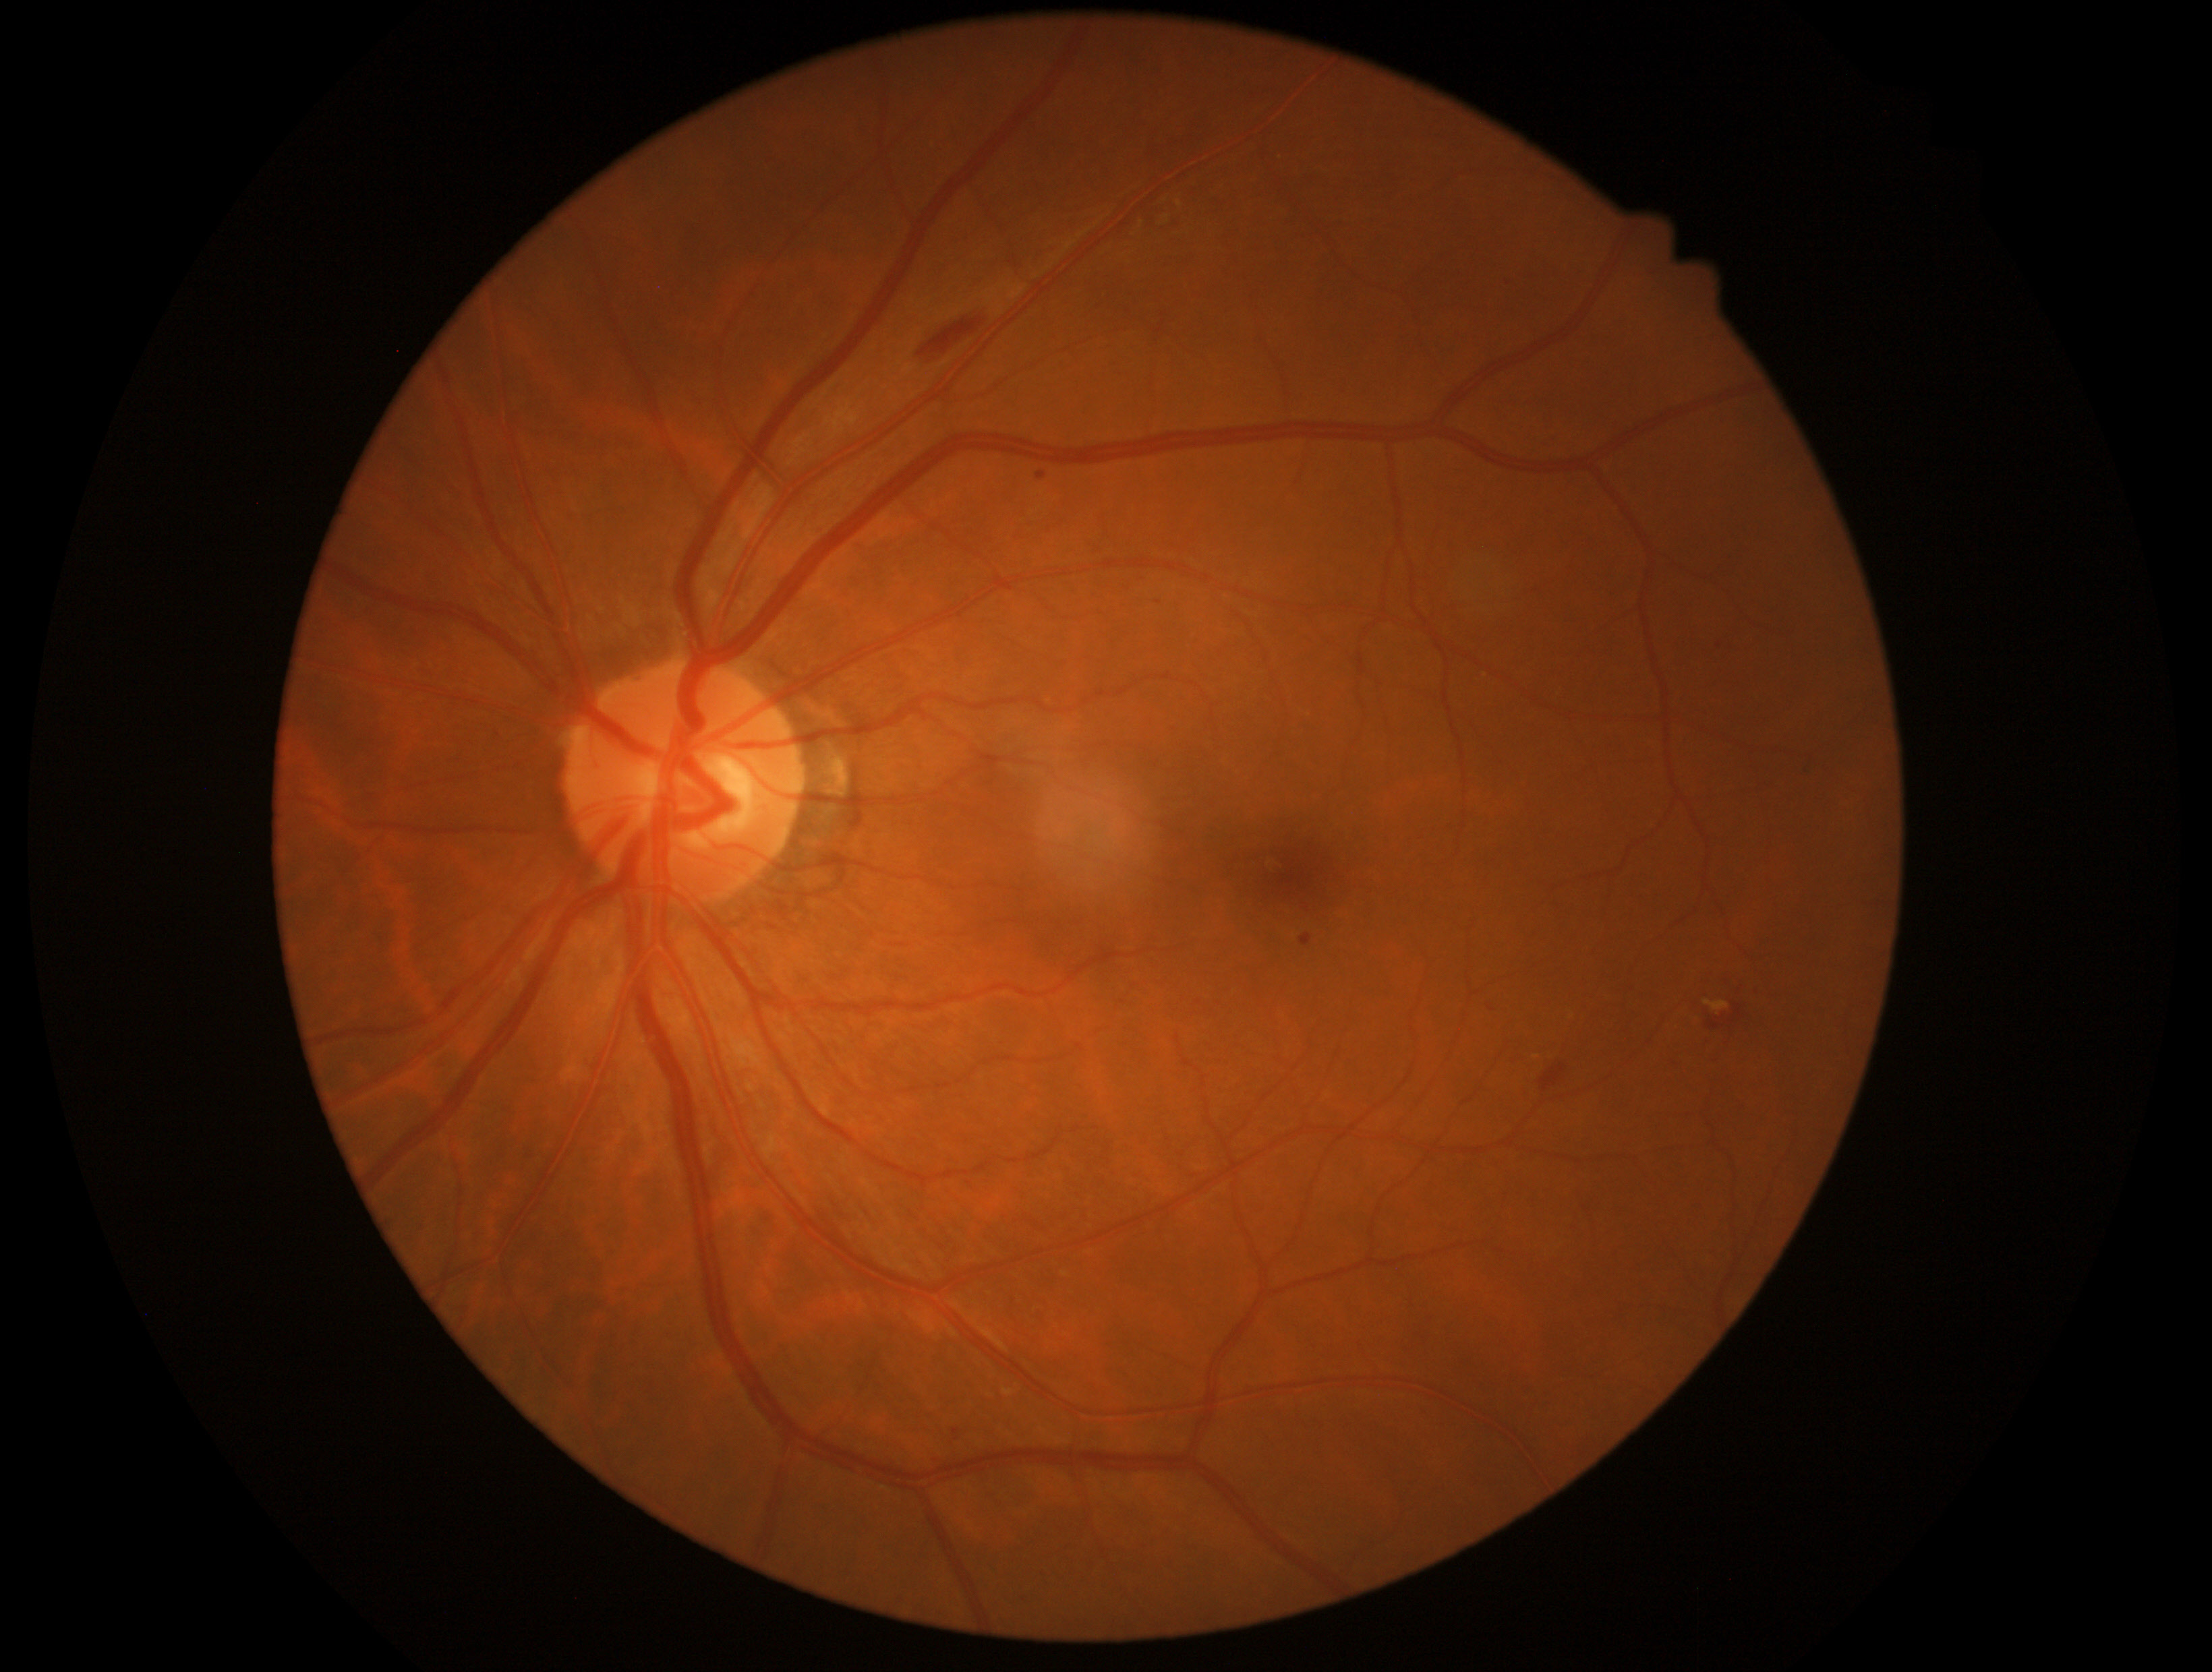 Diabetic retinopathy (DR): 2/4.